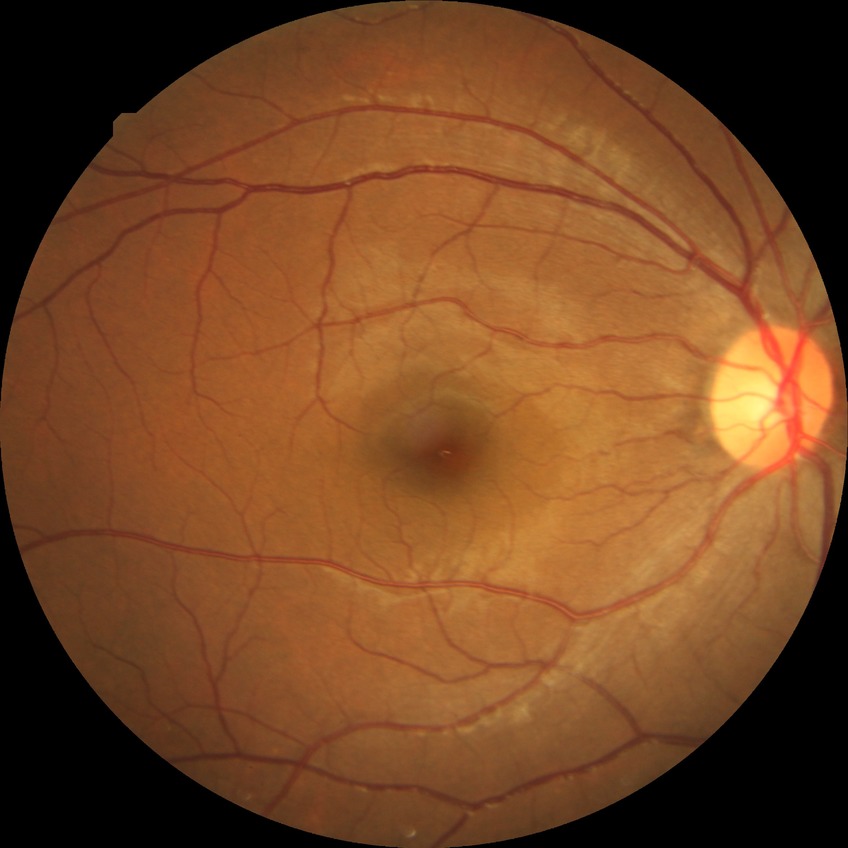 Davis grading: no diabetic retinopathy.